Color fundus photograph:
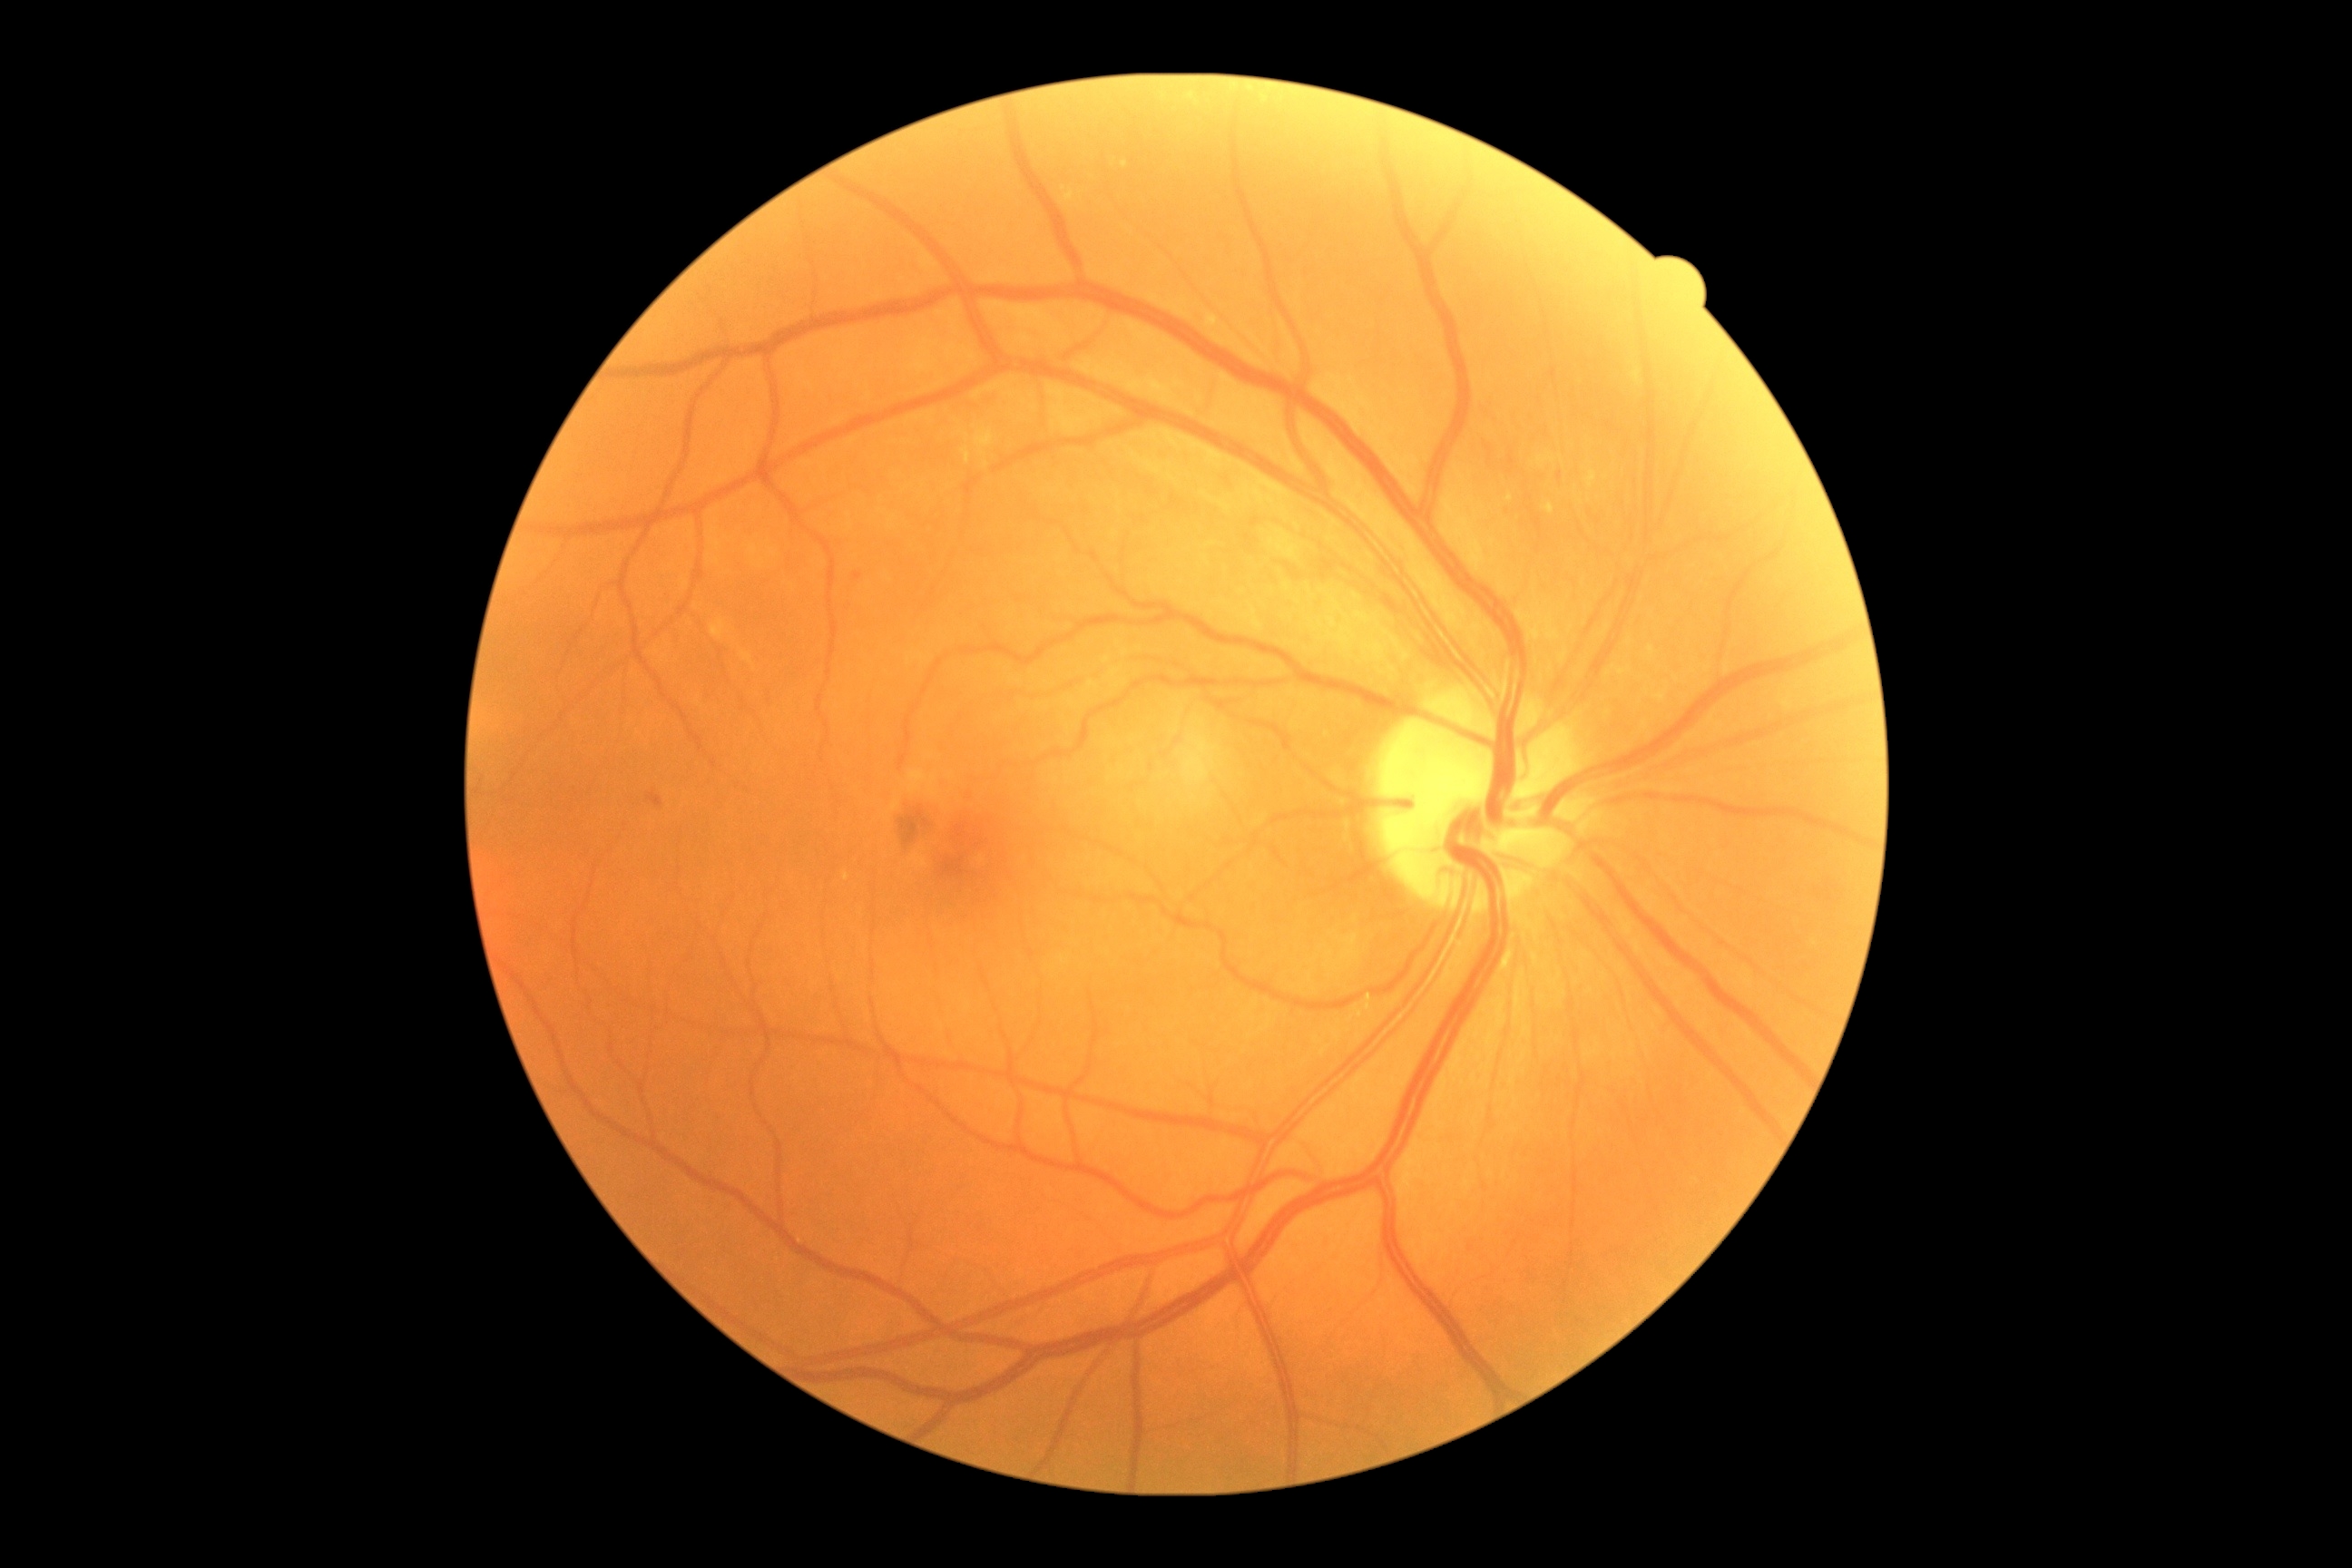

DR class: non-proliferative diabetic retinopathy | DR grade: 2.